Pachymetry 526 µm; axial length (AL) 22.92 mm; visual field mean defect (MD): -0.28 dB:
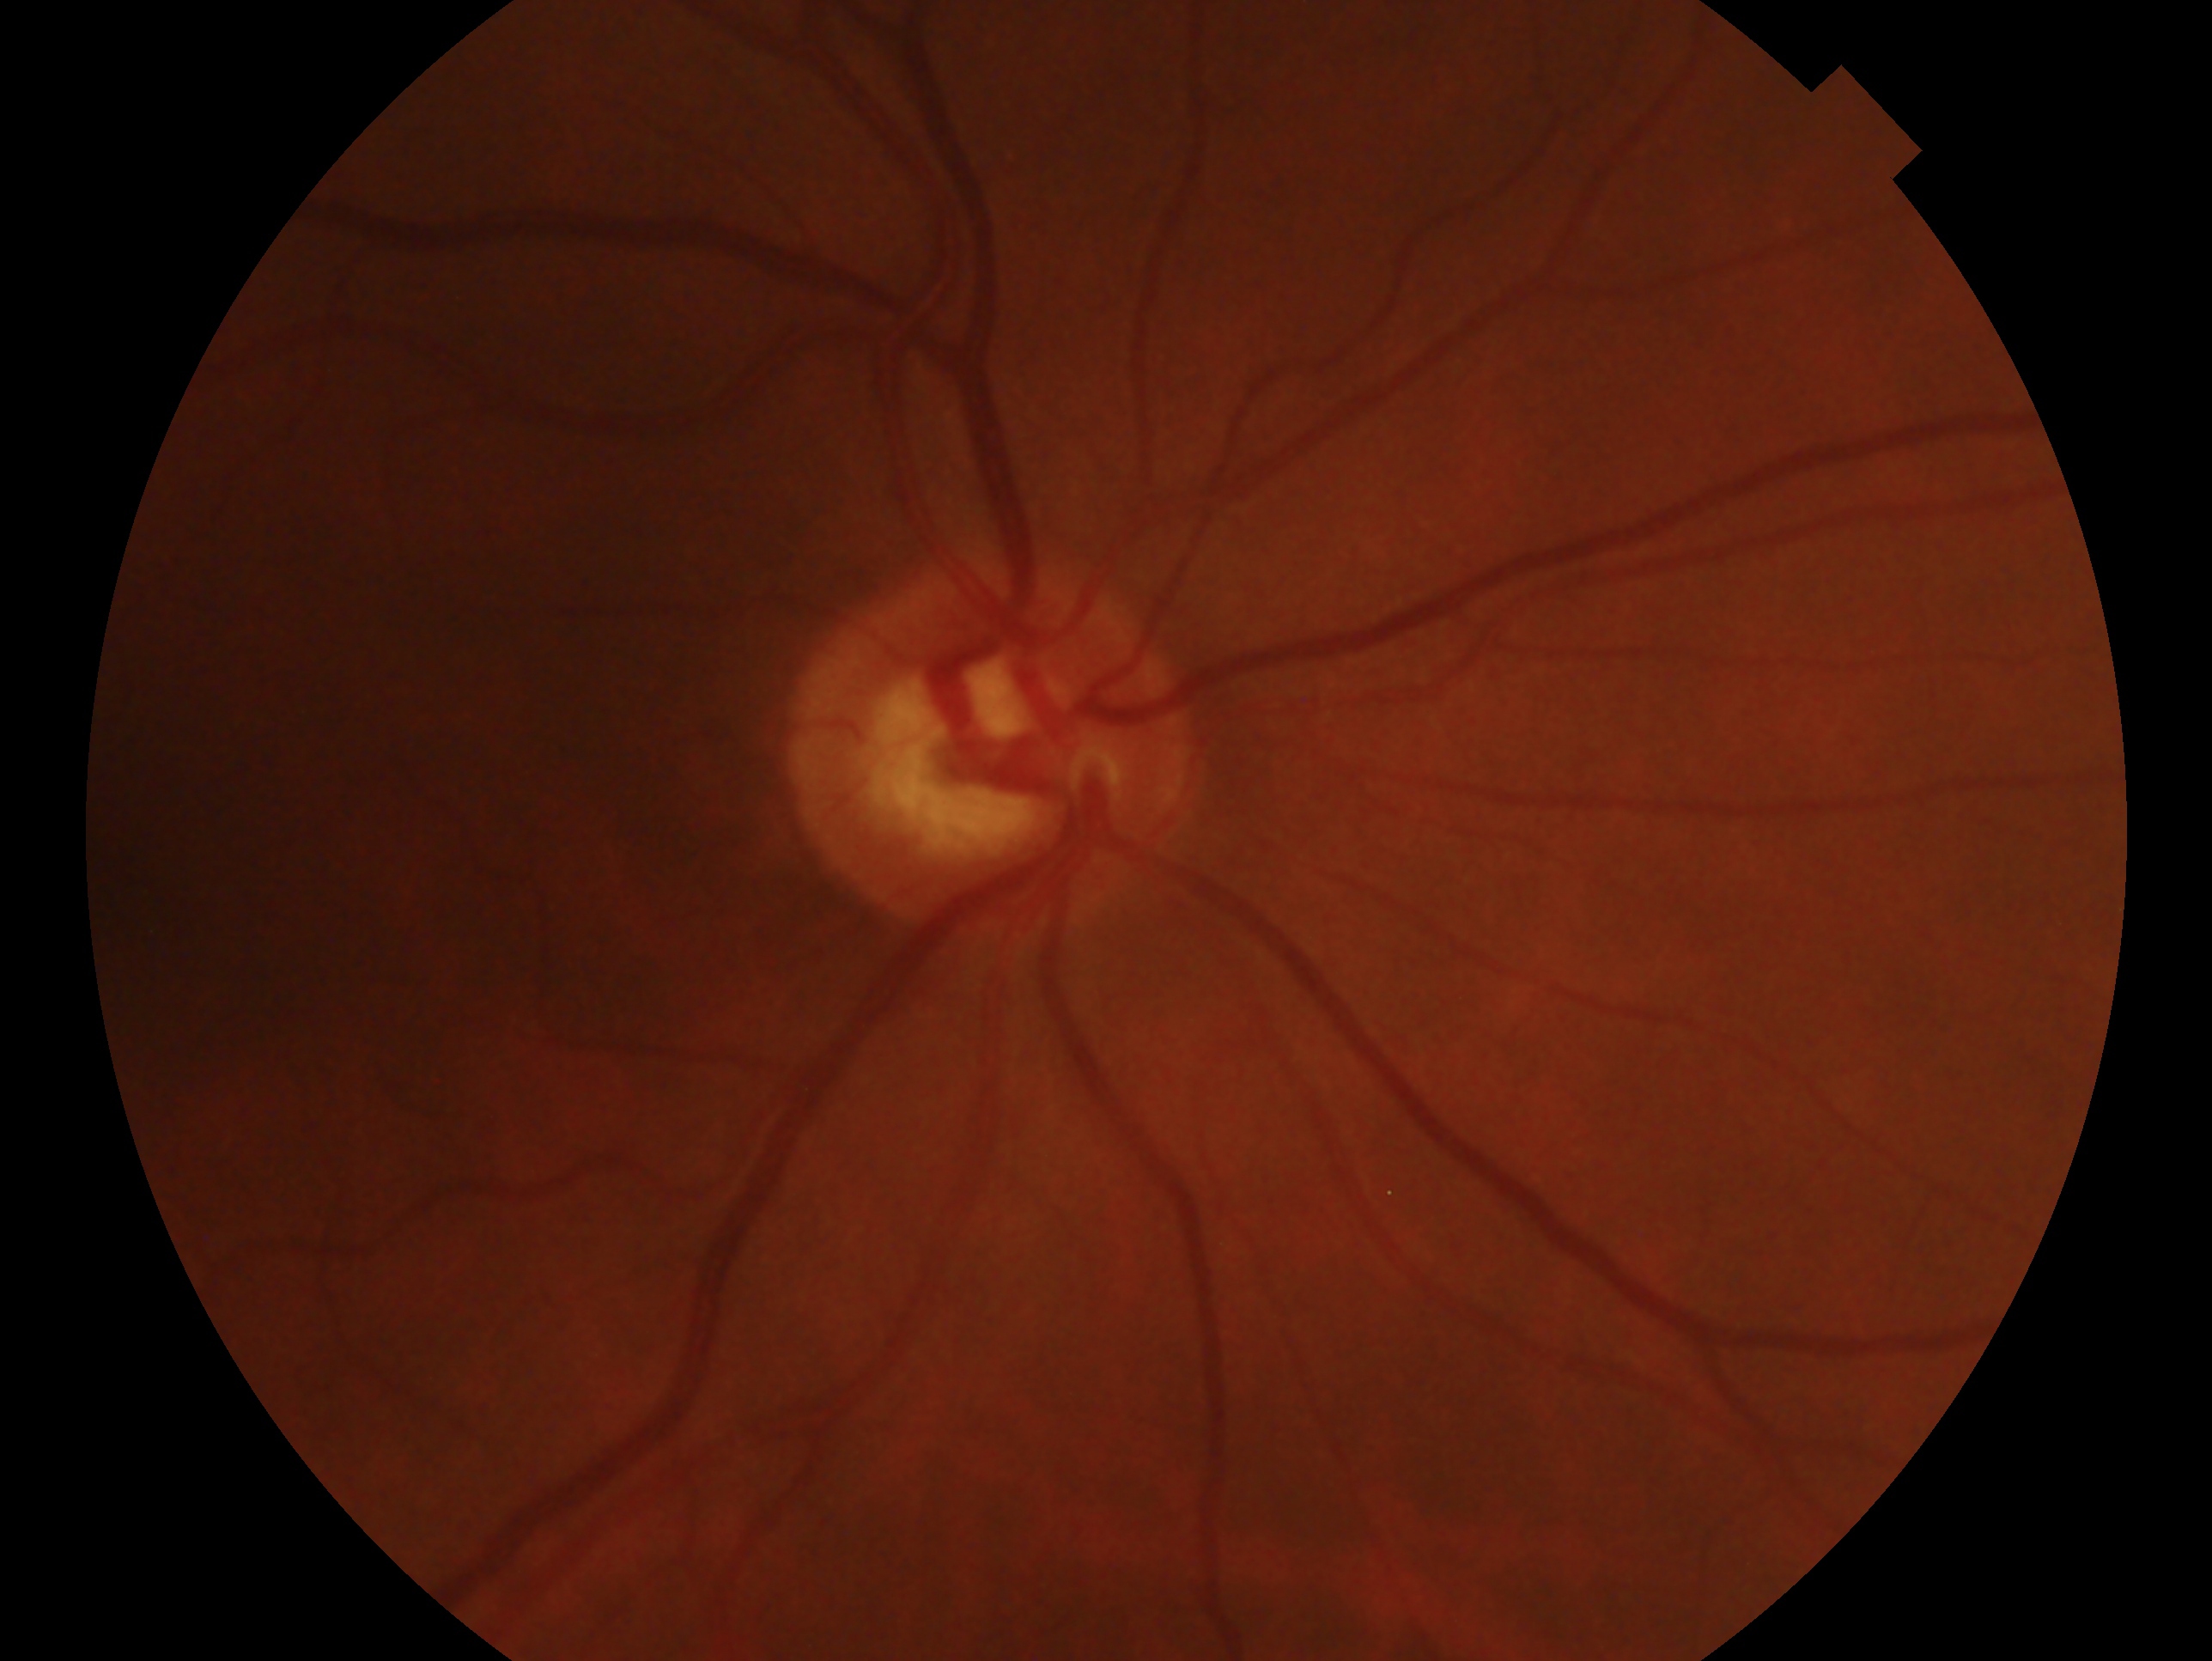

{
  "glaucoma_dx": "suspect",
  "eye": "oculus dexter"
}